Macula-centered, captured after pupil dilation
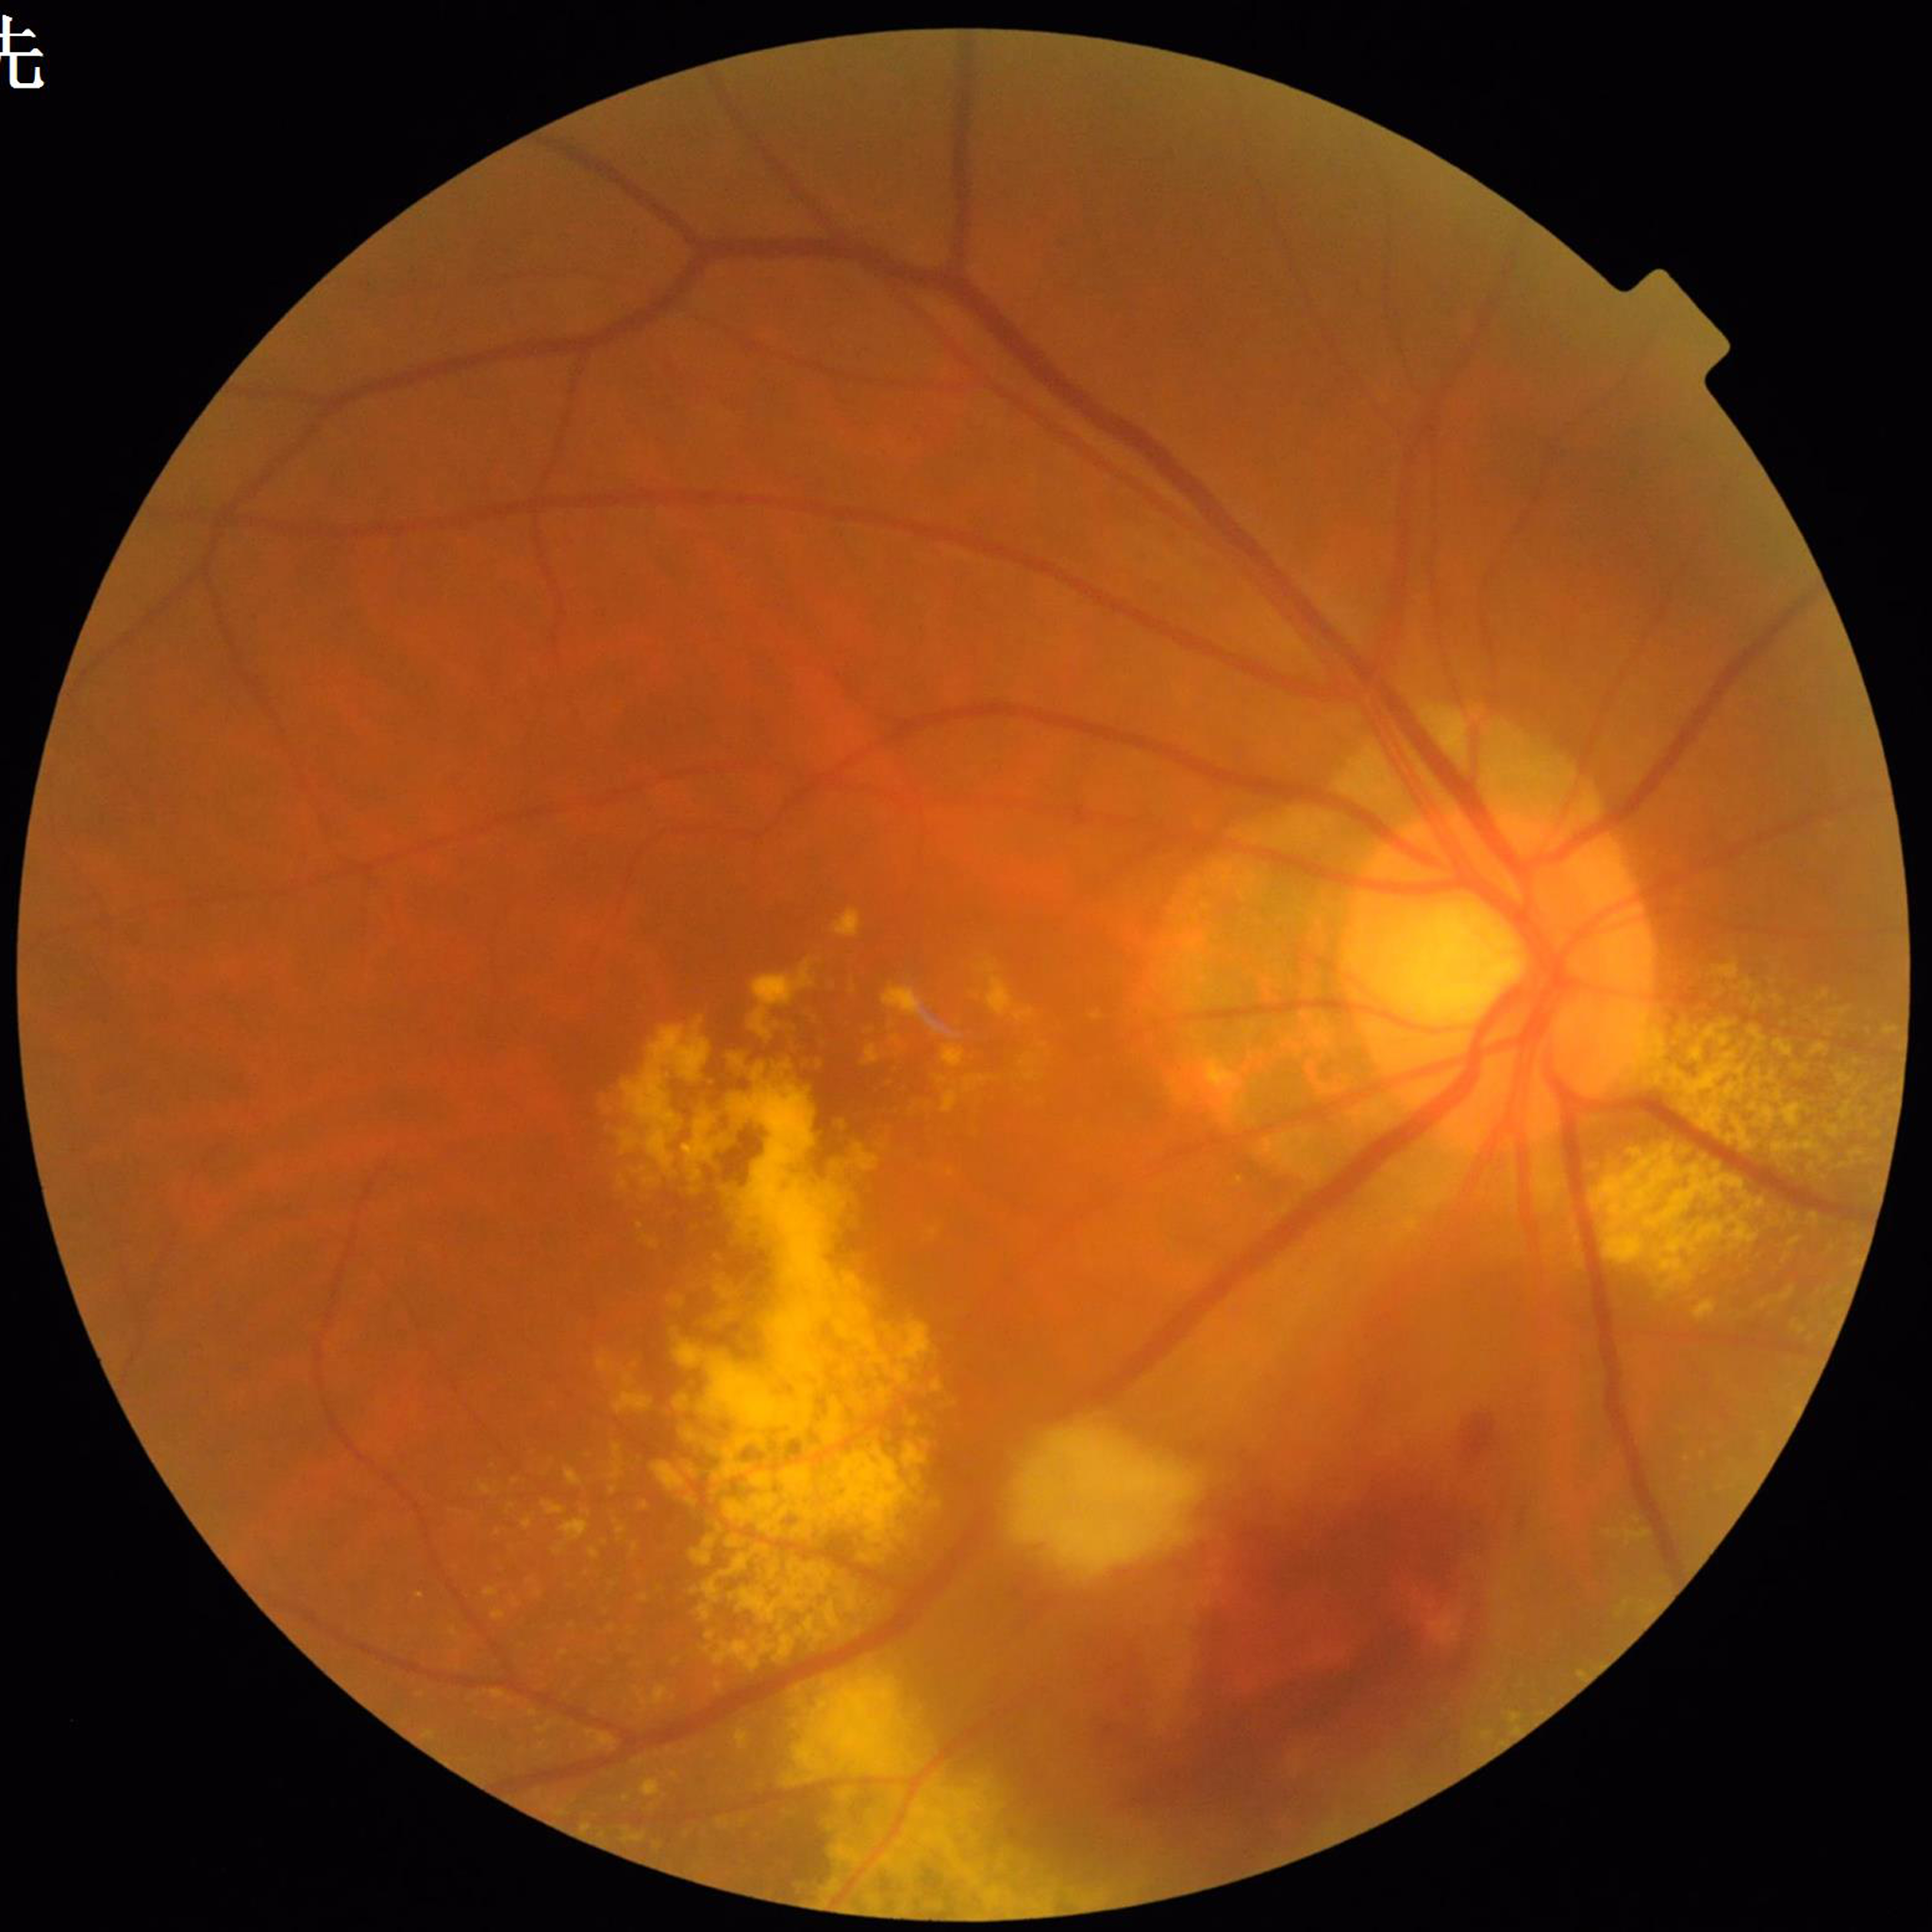

Automated quality assessment: no quality issues identified. From a patient with AMD.